45-degree field of view.
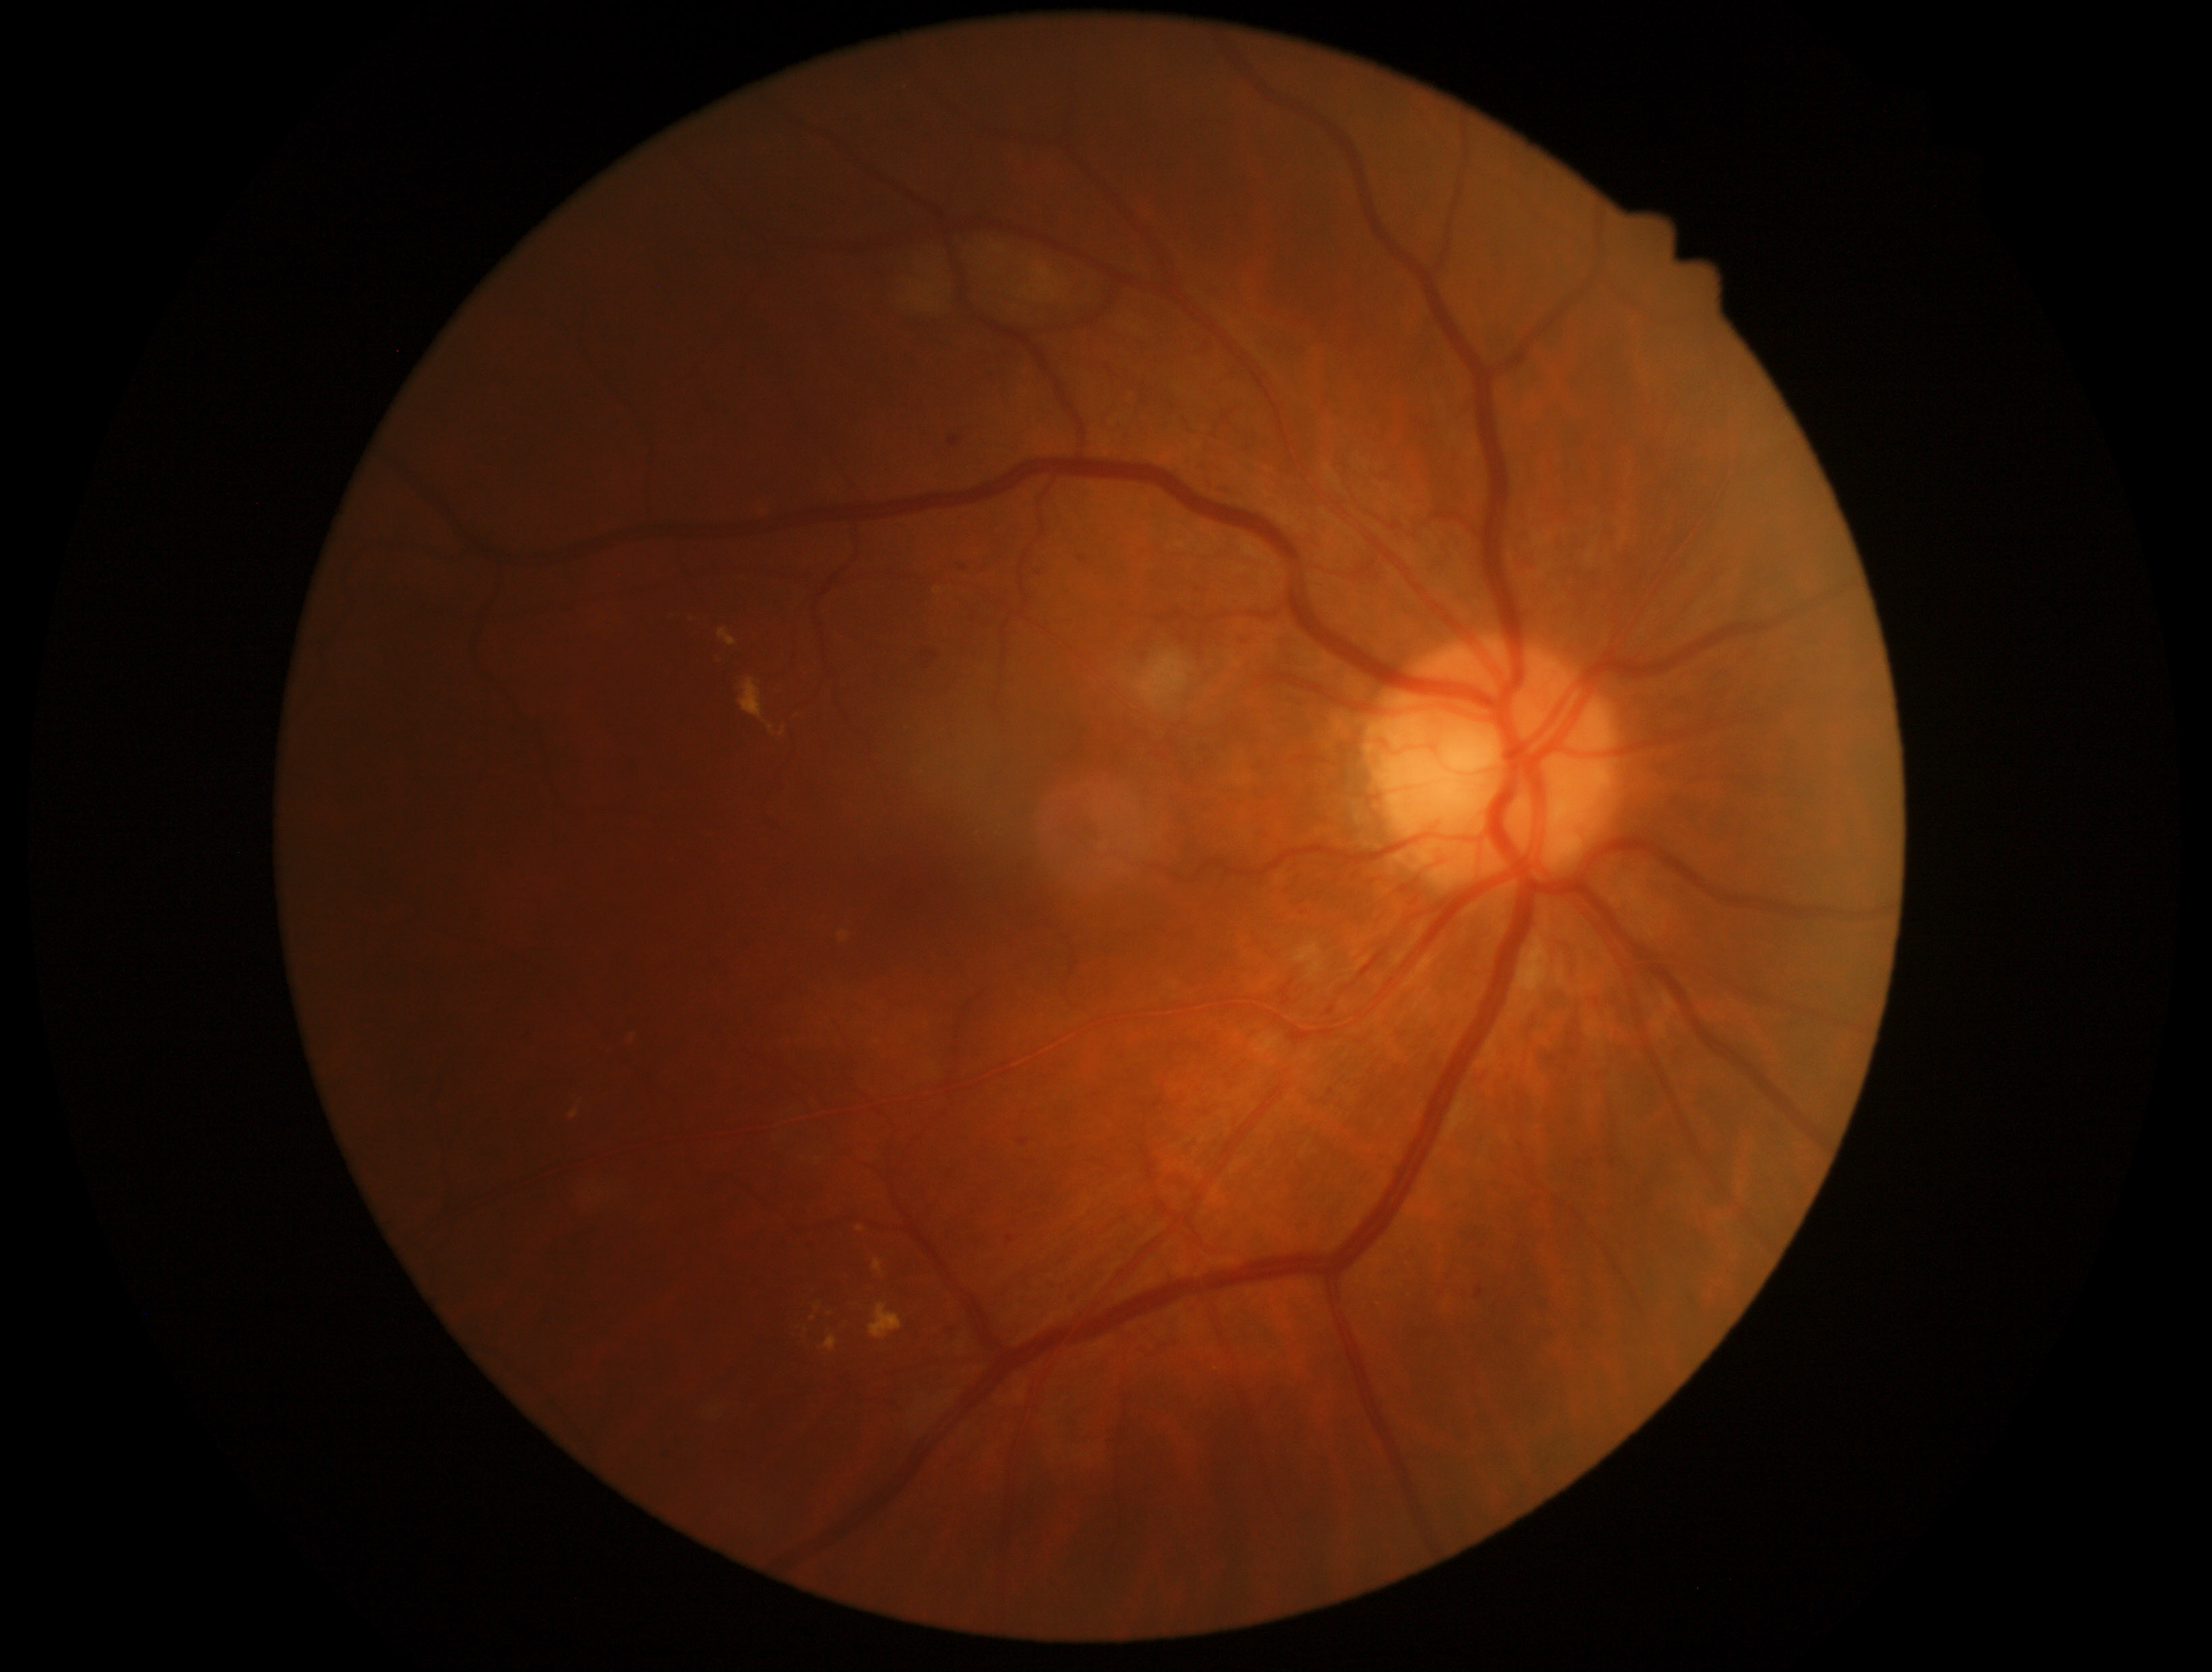
{"dr_grade": "grade 2"}